FOV: 45 degrees — 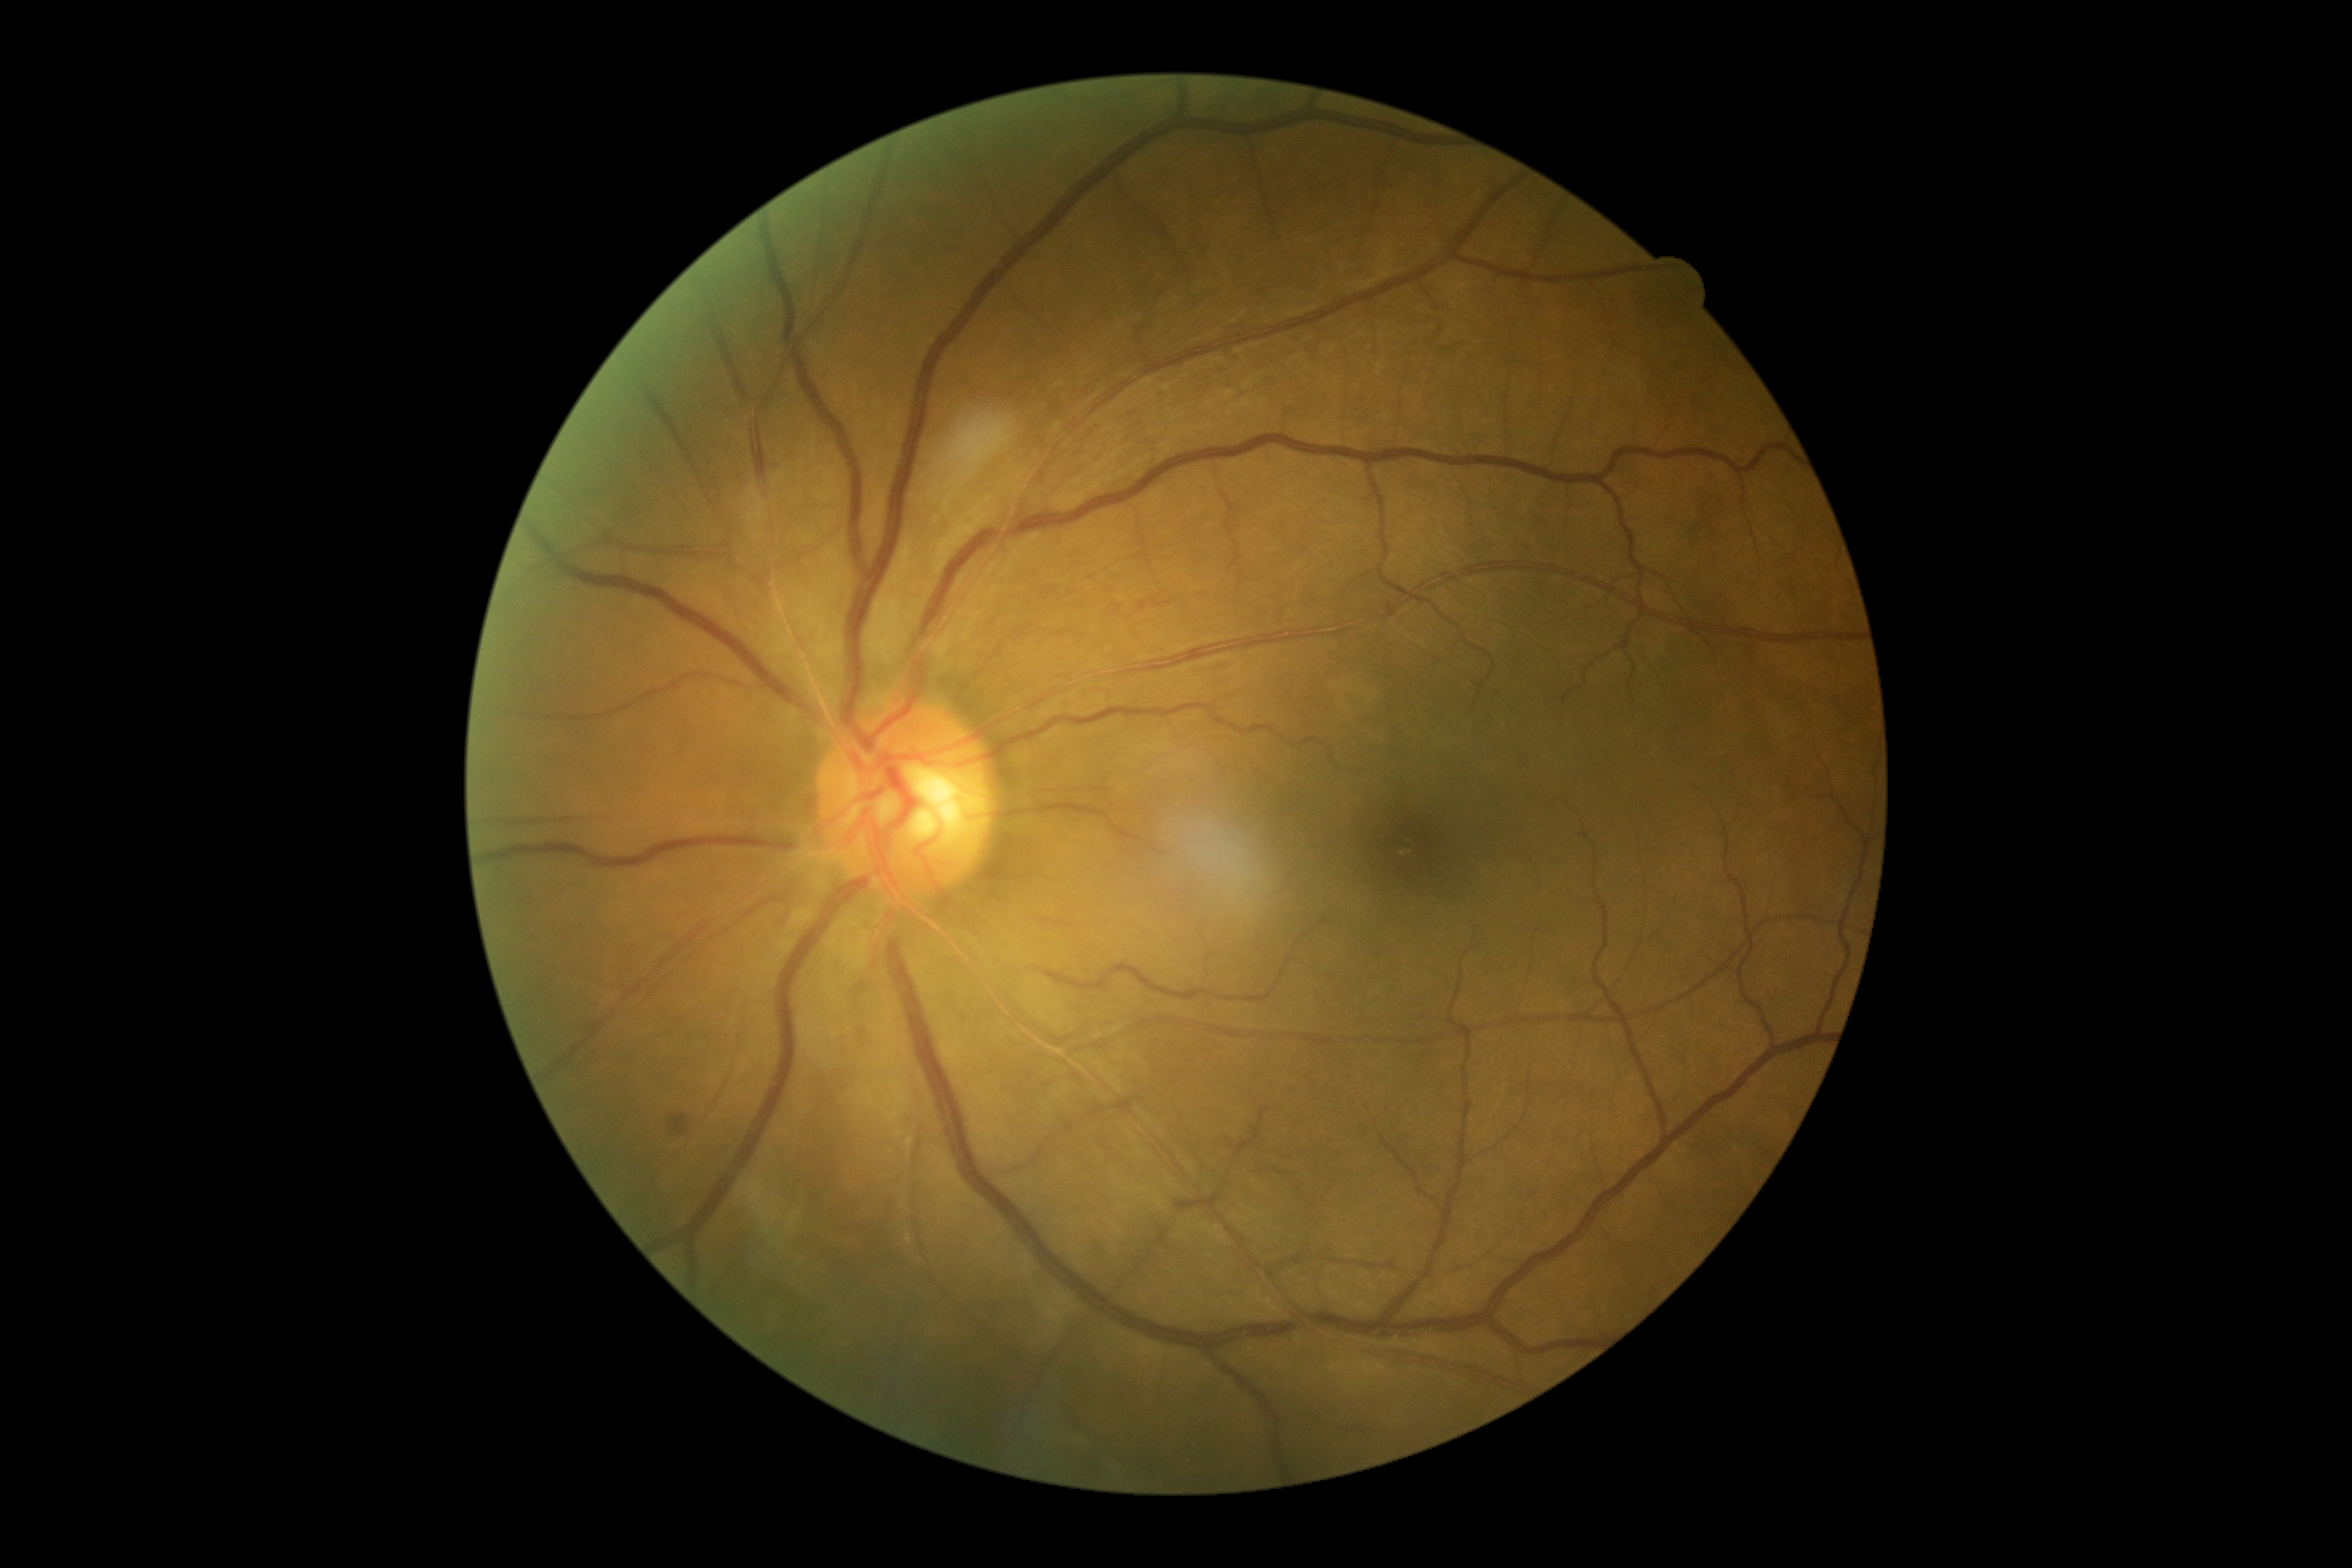

Diabetic retinopathy (DR) is grade 2 — more than just microaneurysms but less than severe NPDR
microaneurysms (MAs) = none identified
hard exudates (EXs) = none identified
hemorrhages (HEs) = 670, 1115, 689, 1136
soft exudates (SEs) = none identified